FOV: 45 degrees:
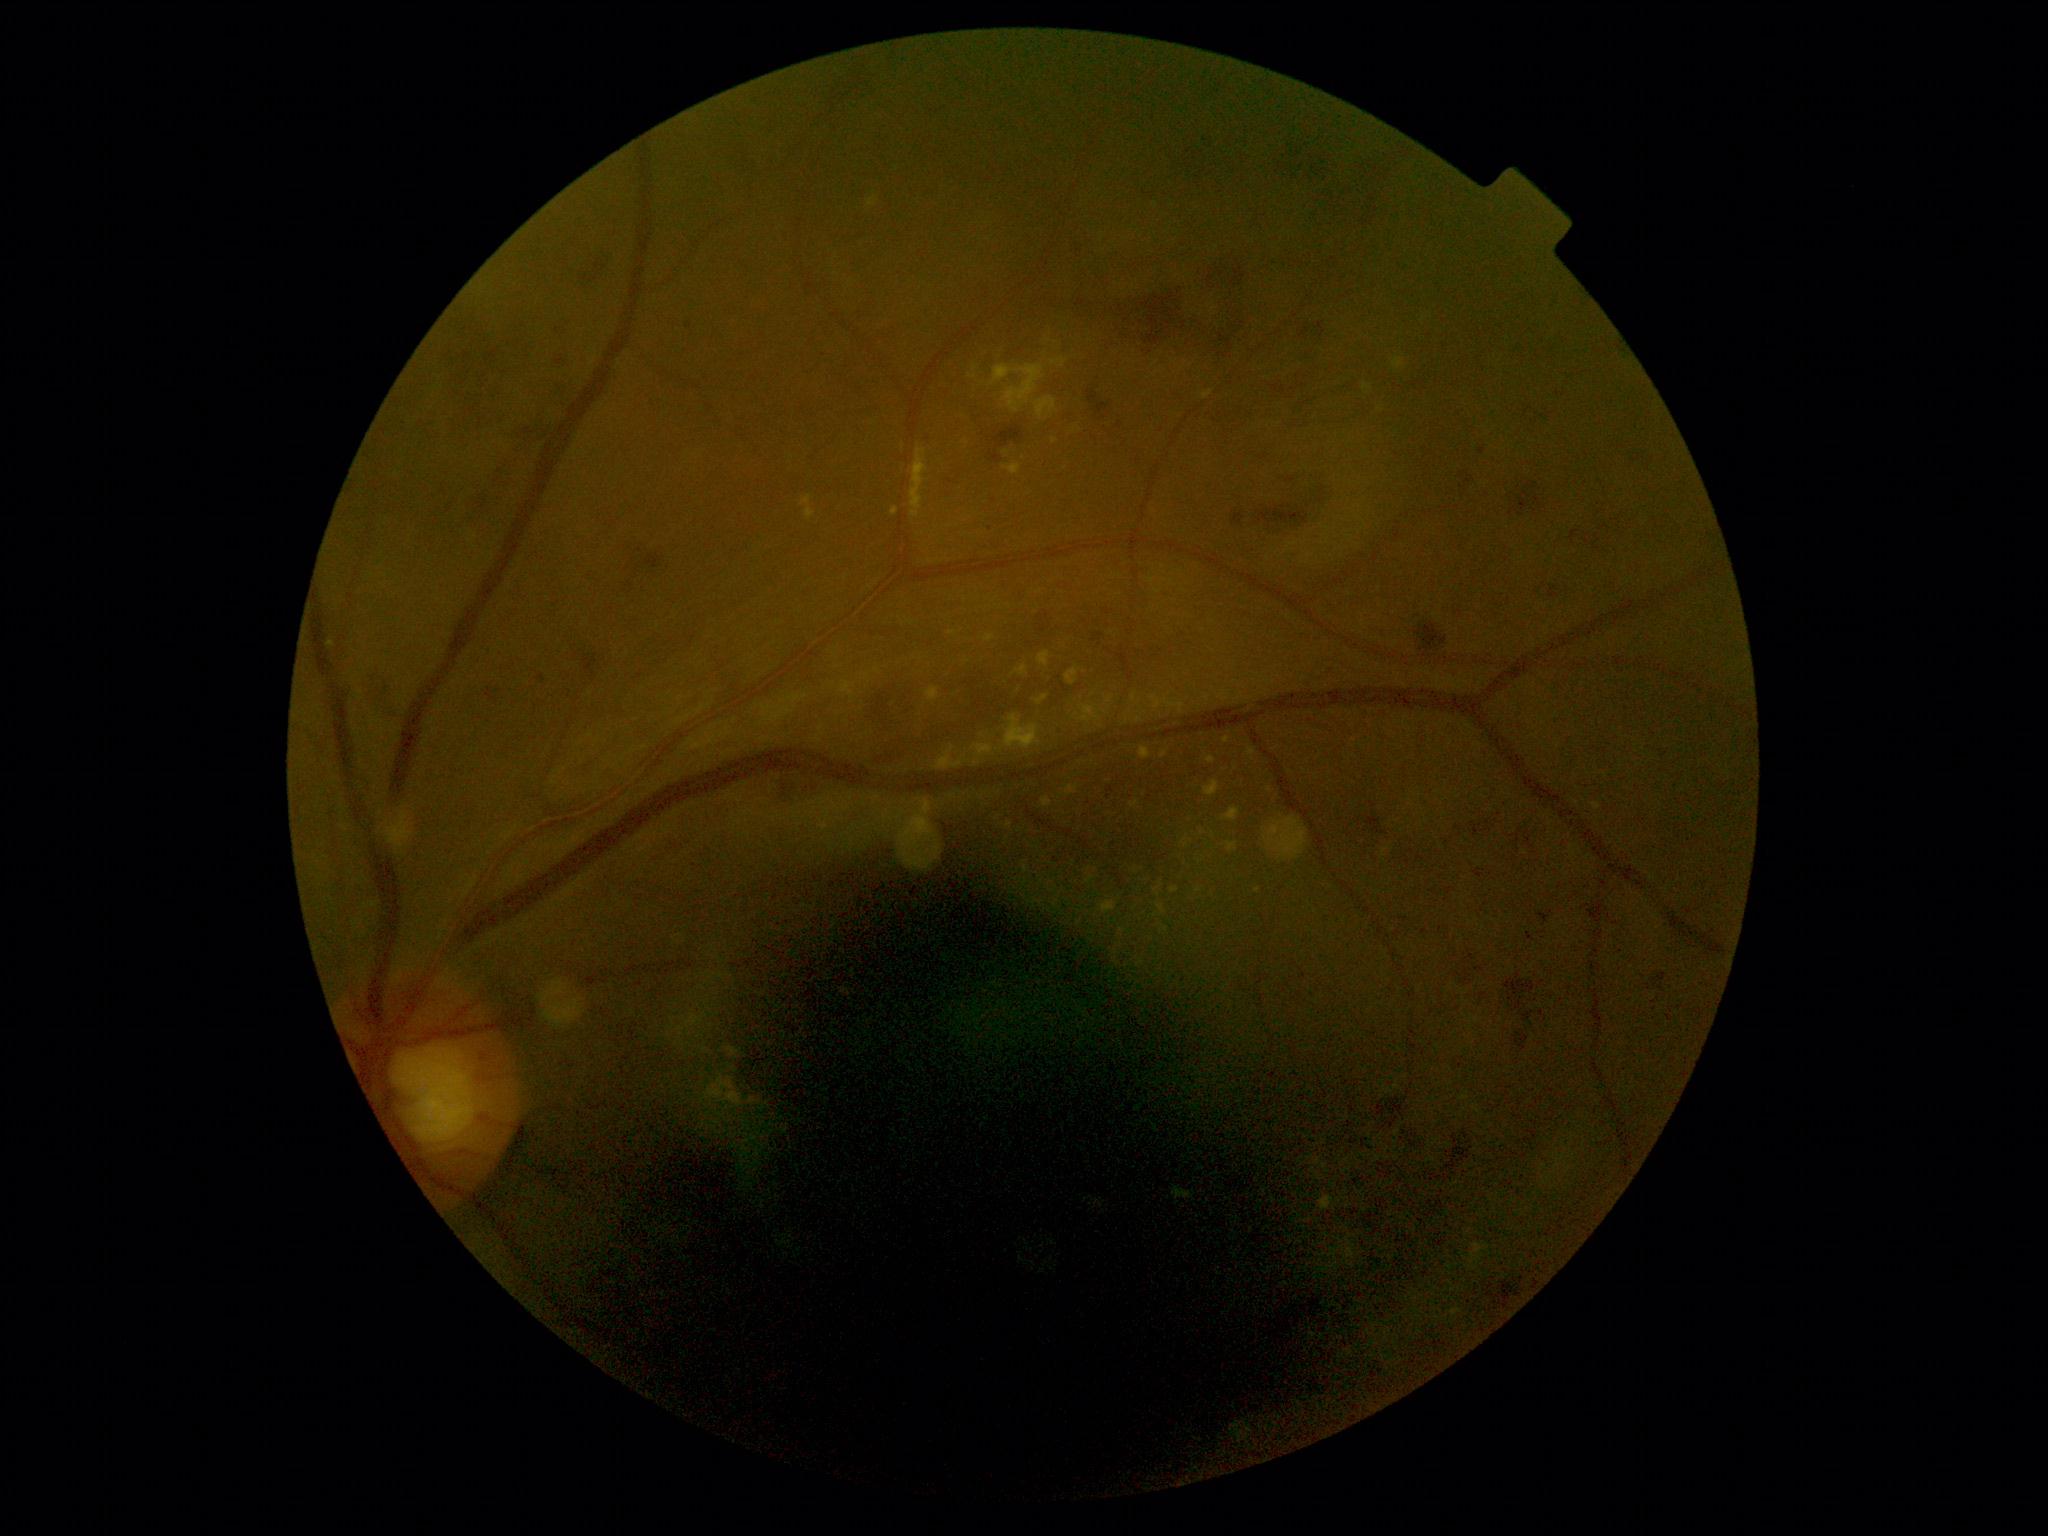

DR grade: 2. Disease class: non-proliferative diabetic retinopathy.